FOV: 45 degrees
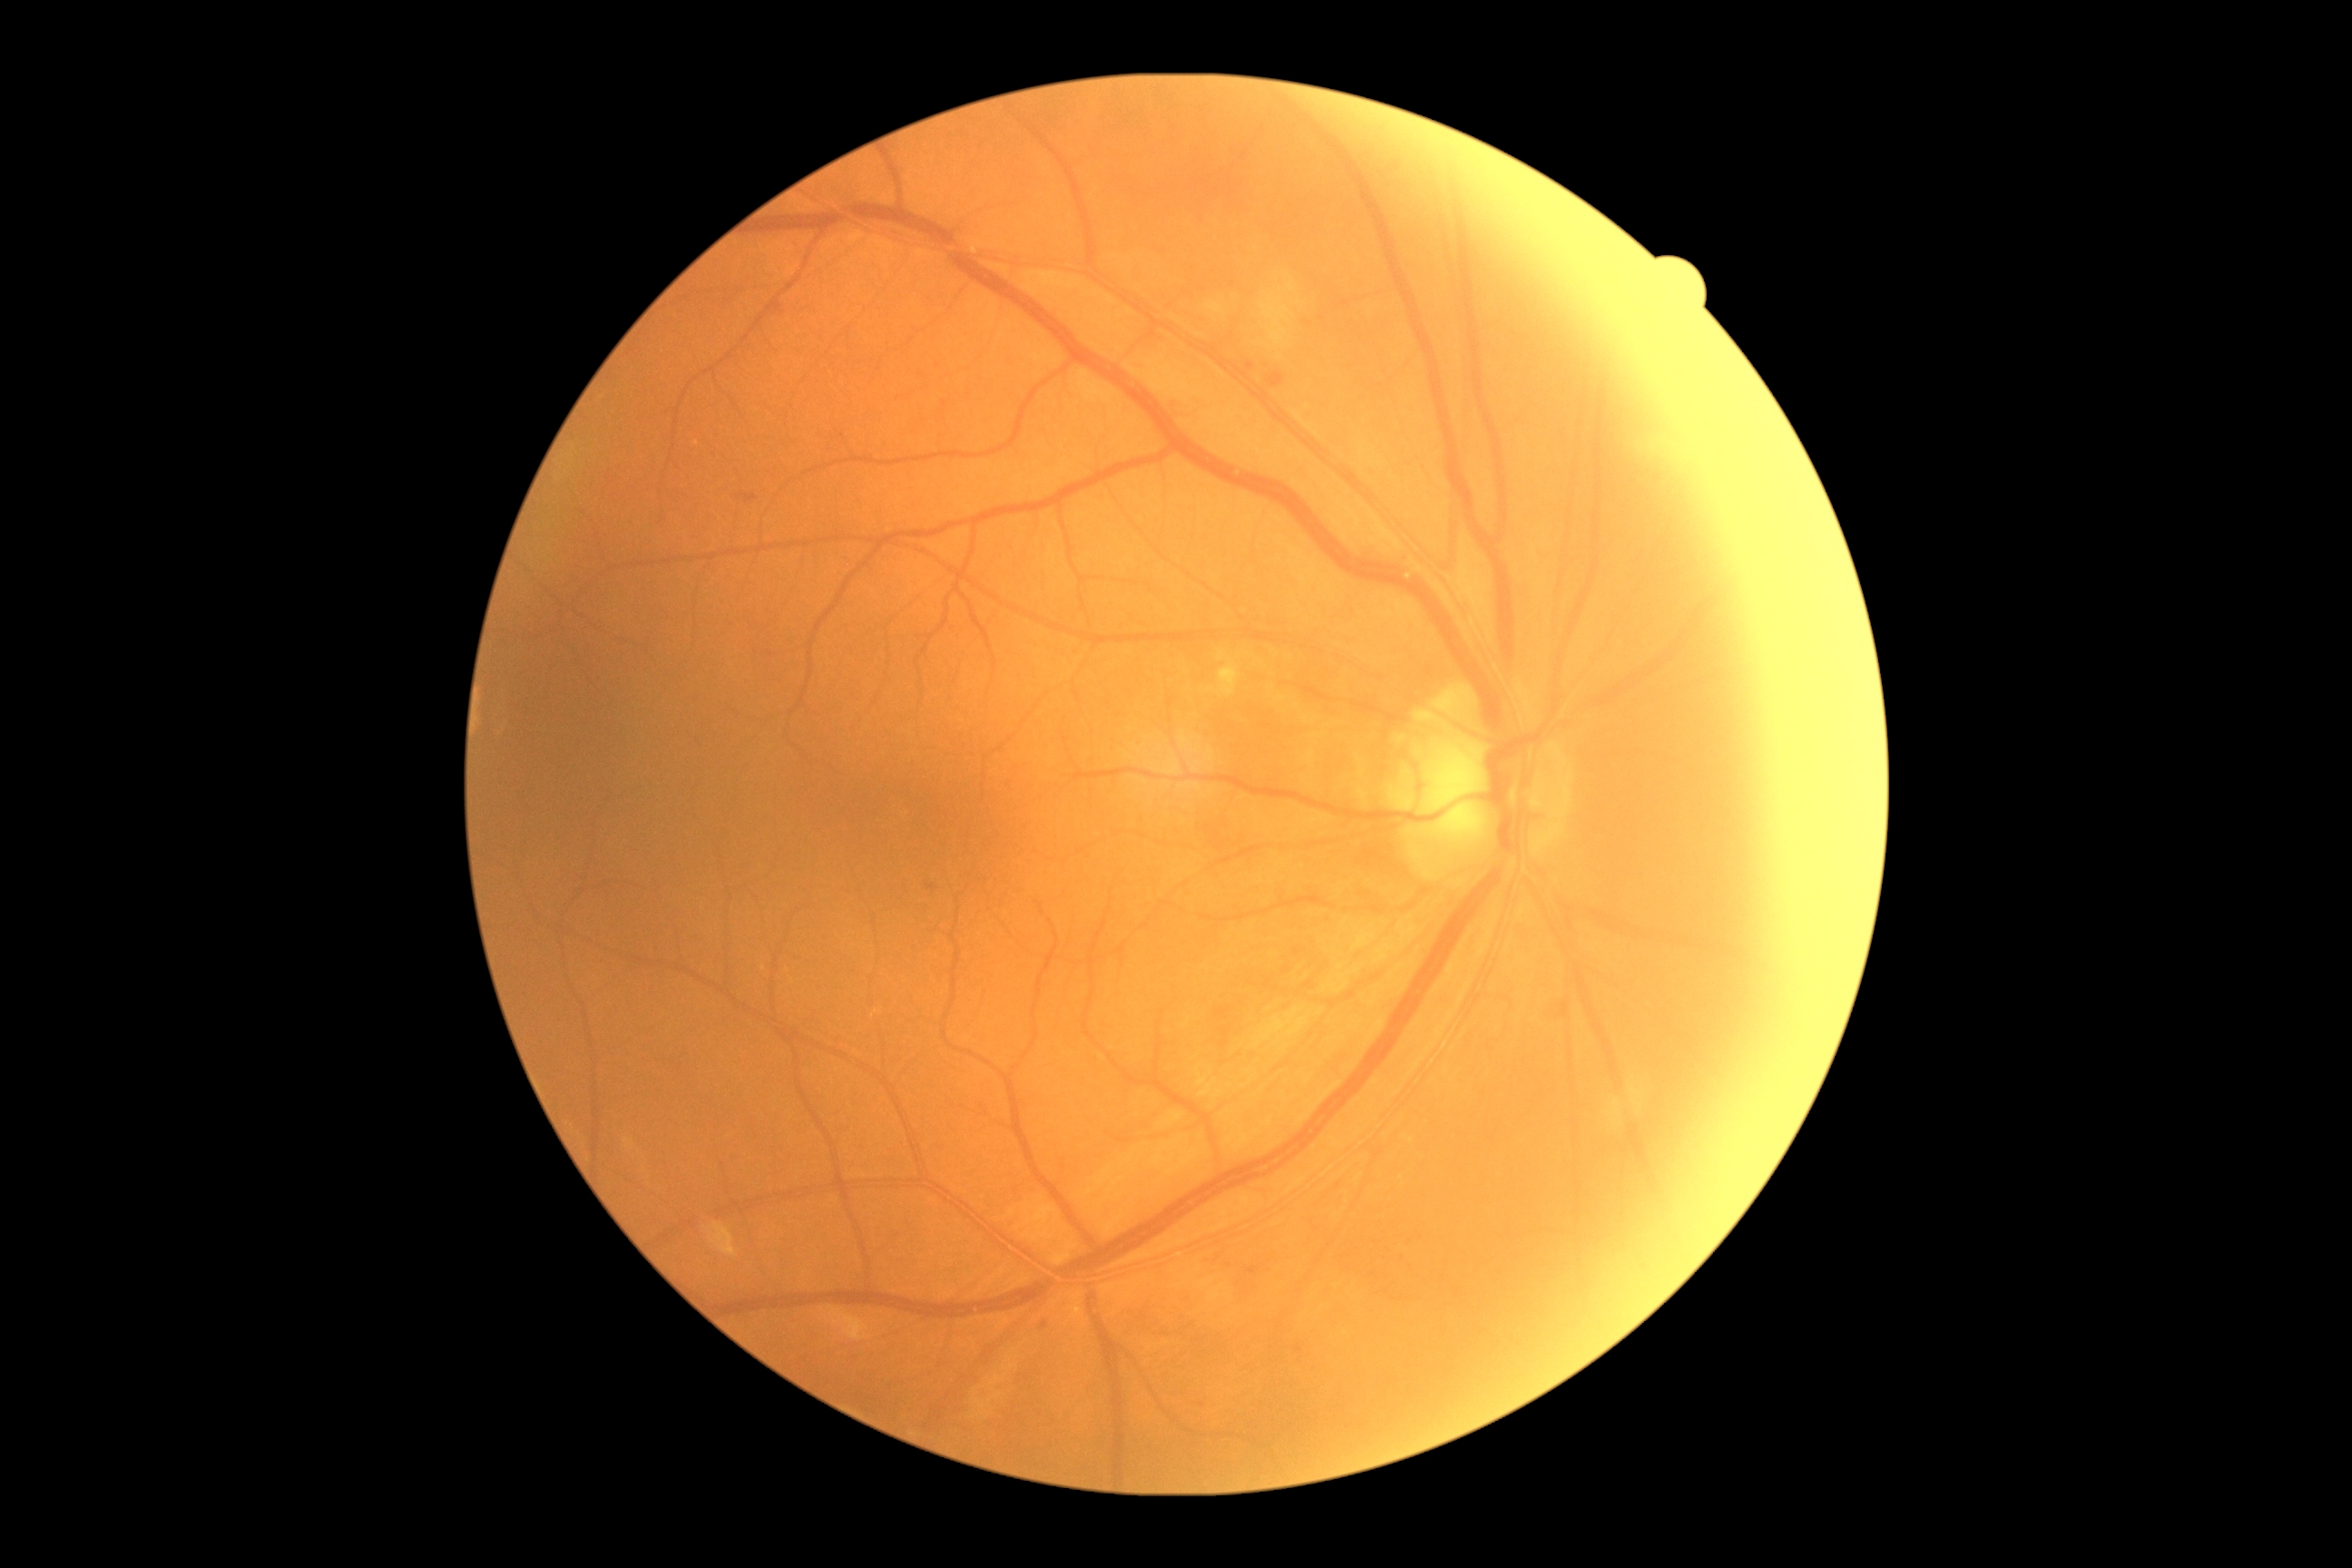

Diabetic retinopathy grade is 2/4 — more than just microaneurysms but less than severe NPDR.
Disease class: non-proliferative diabetic retinopathy.